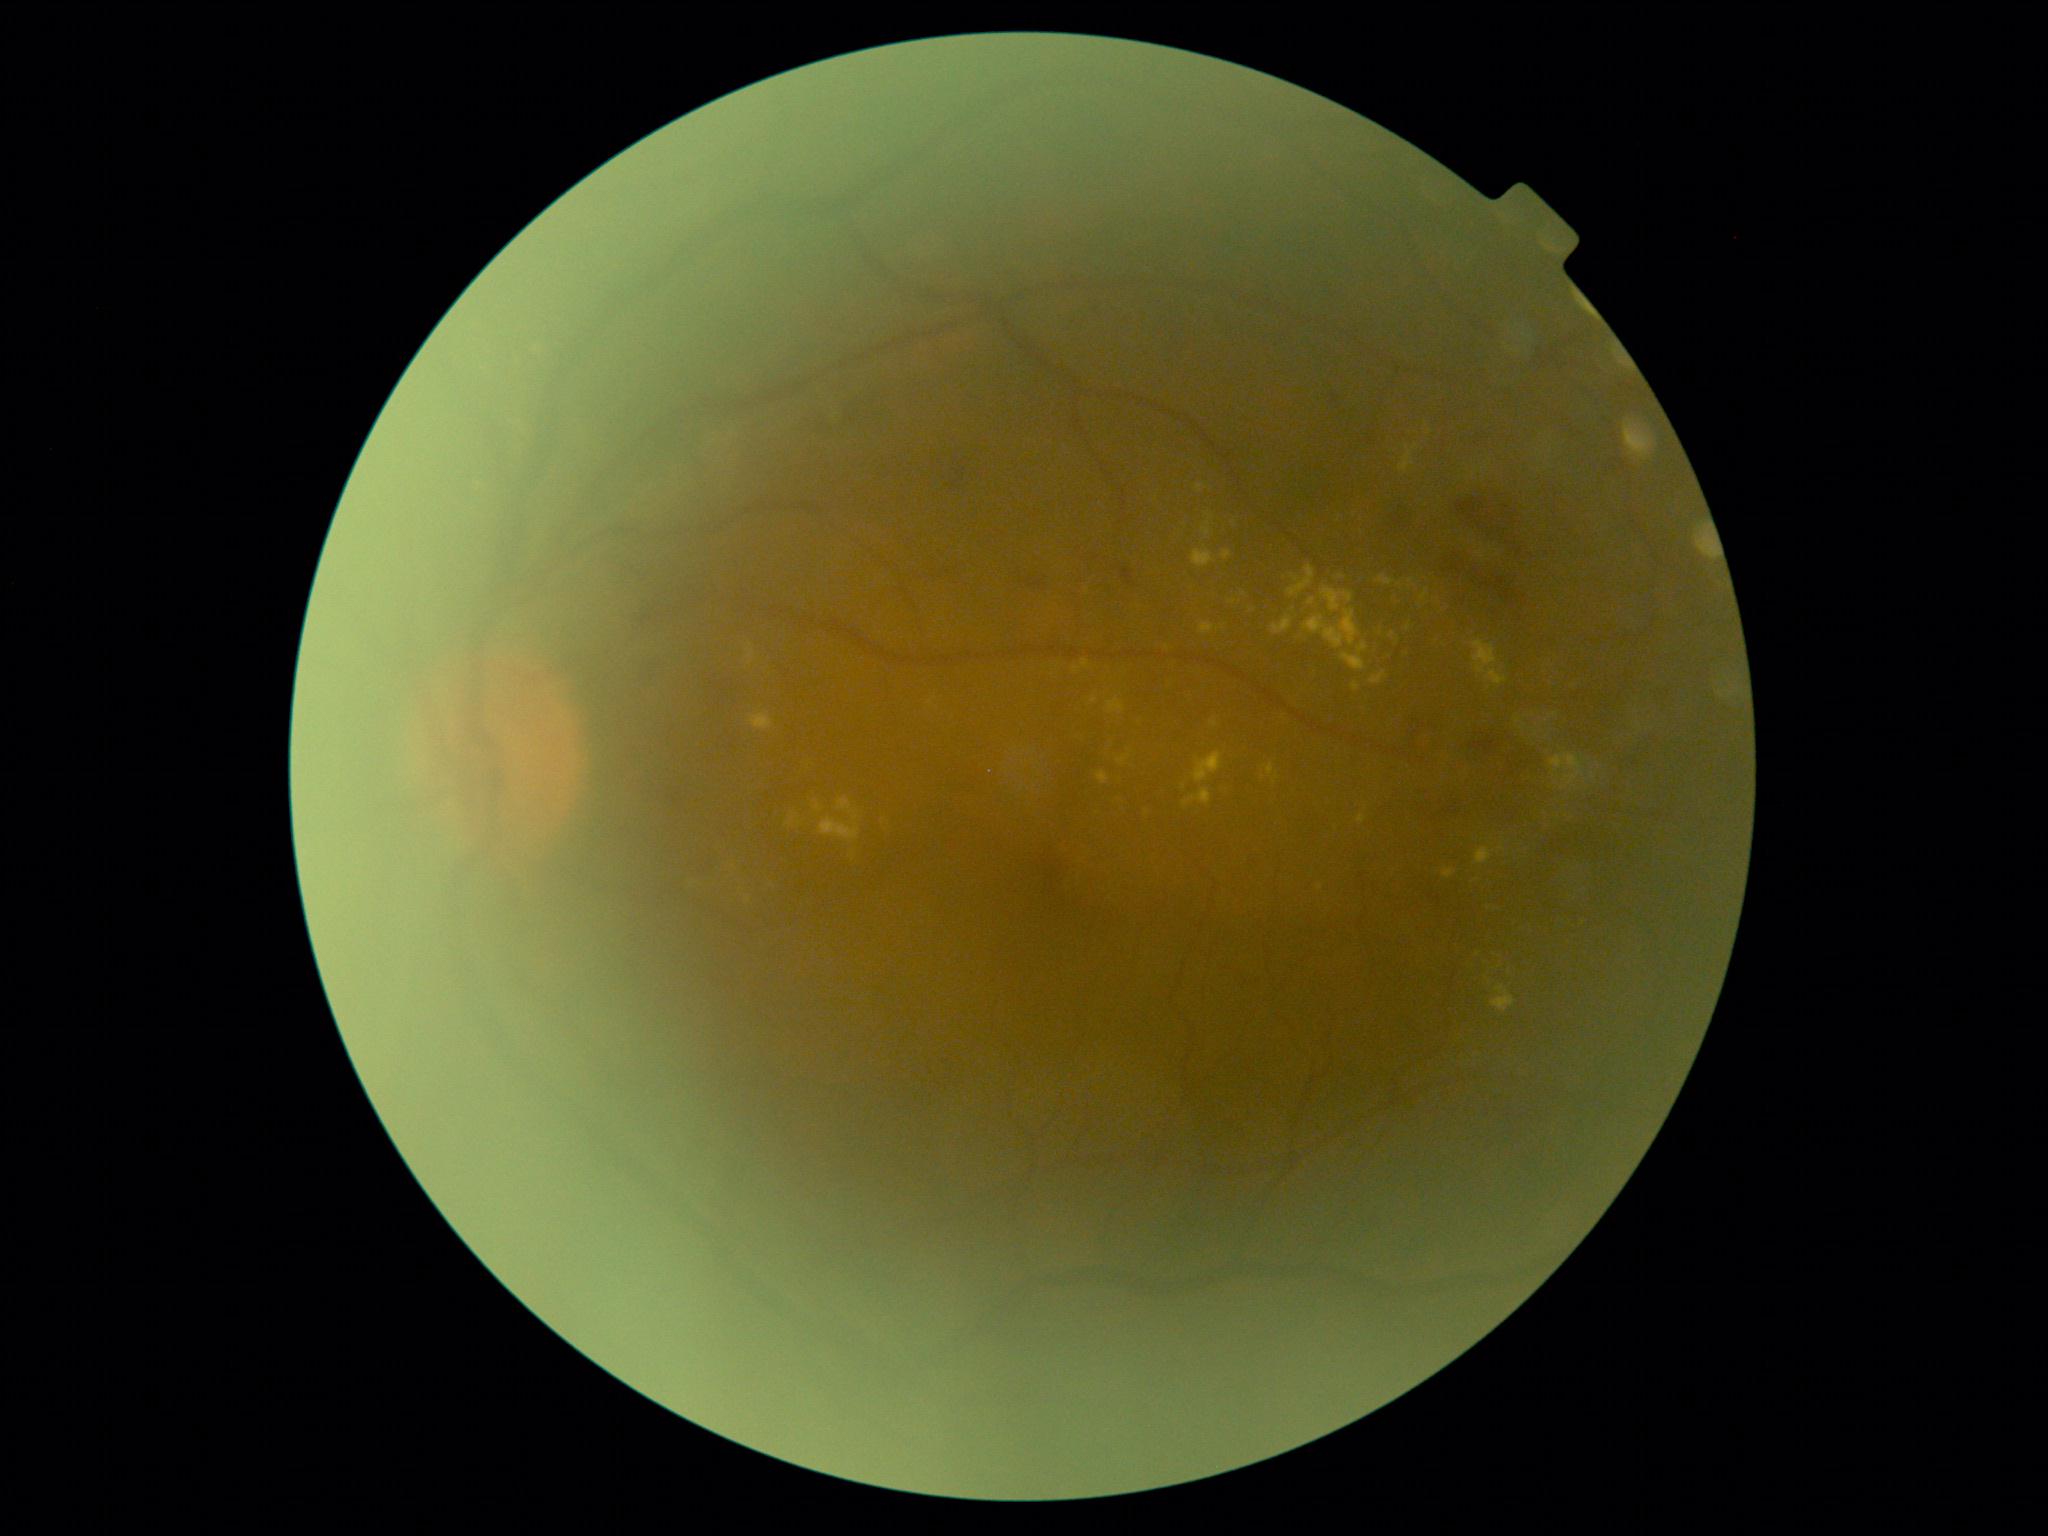 DR stage is grade 2 (moderate NPDR).